FOV: 45 degrees, 2212 x 1659 pixels, retinal fundus photograph
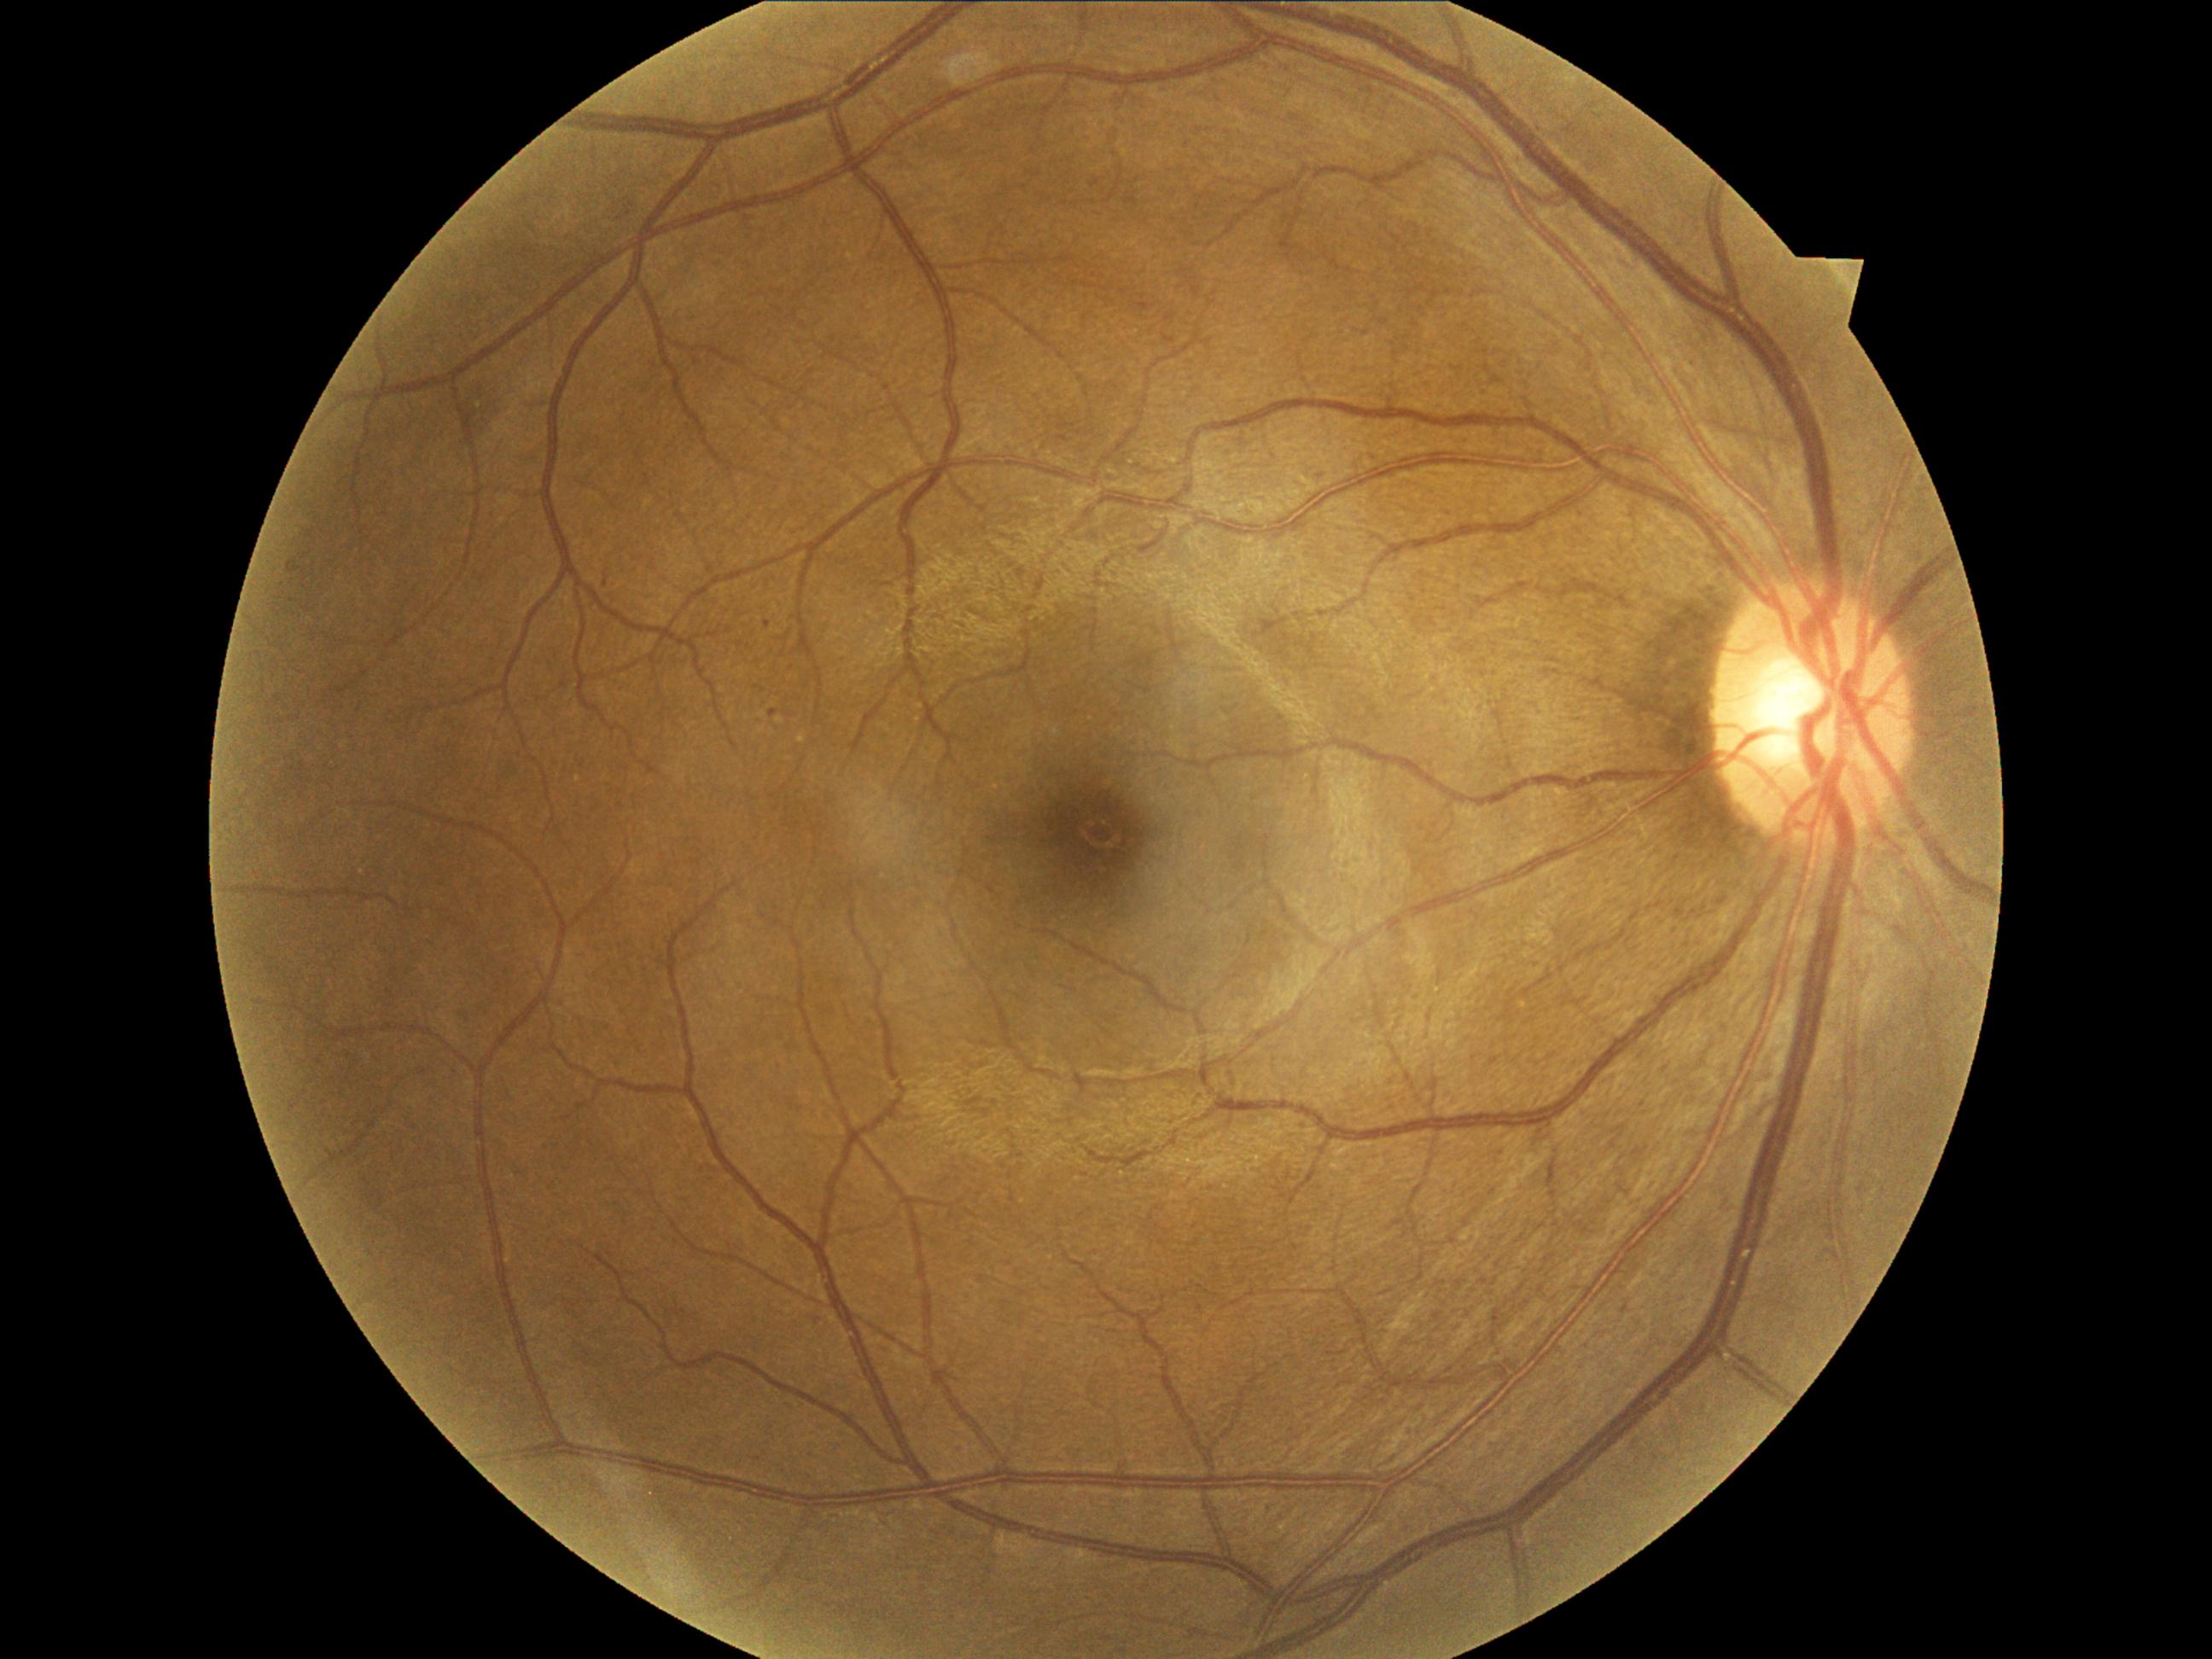
{
  "dr_category": "non-proliferative diabetic retinopathy",
  "dr_grade": "grade 2"
}